2212 by 1659 pixels — 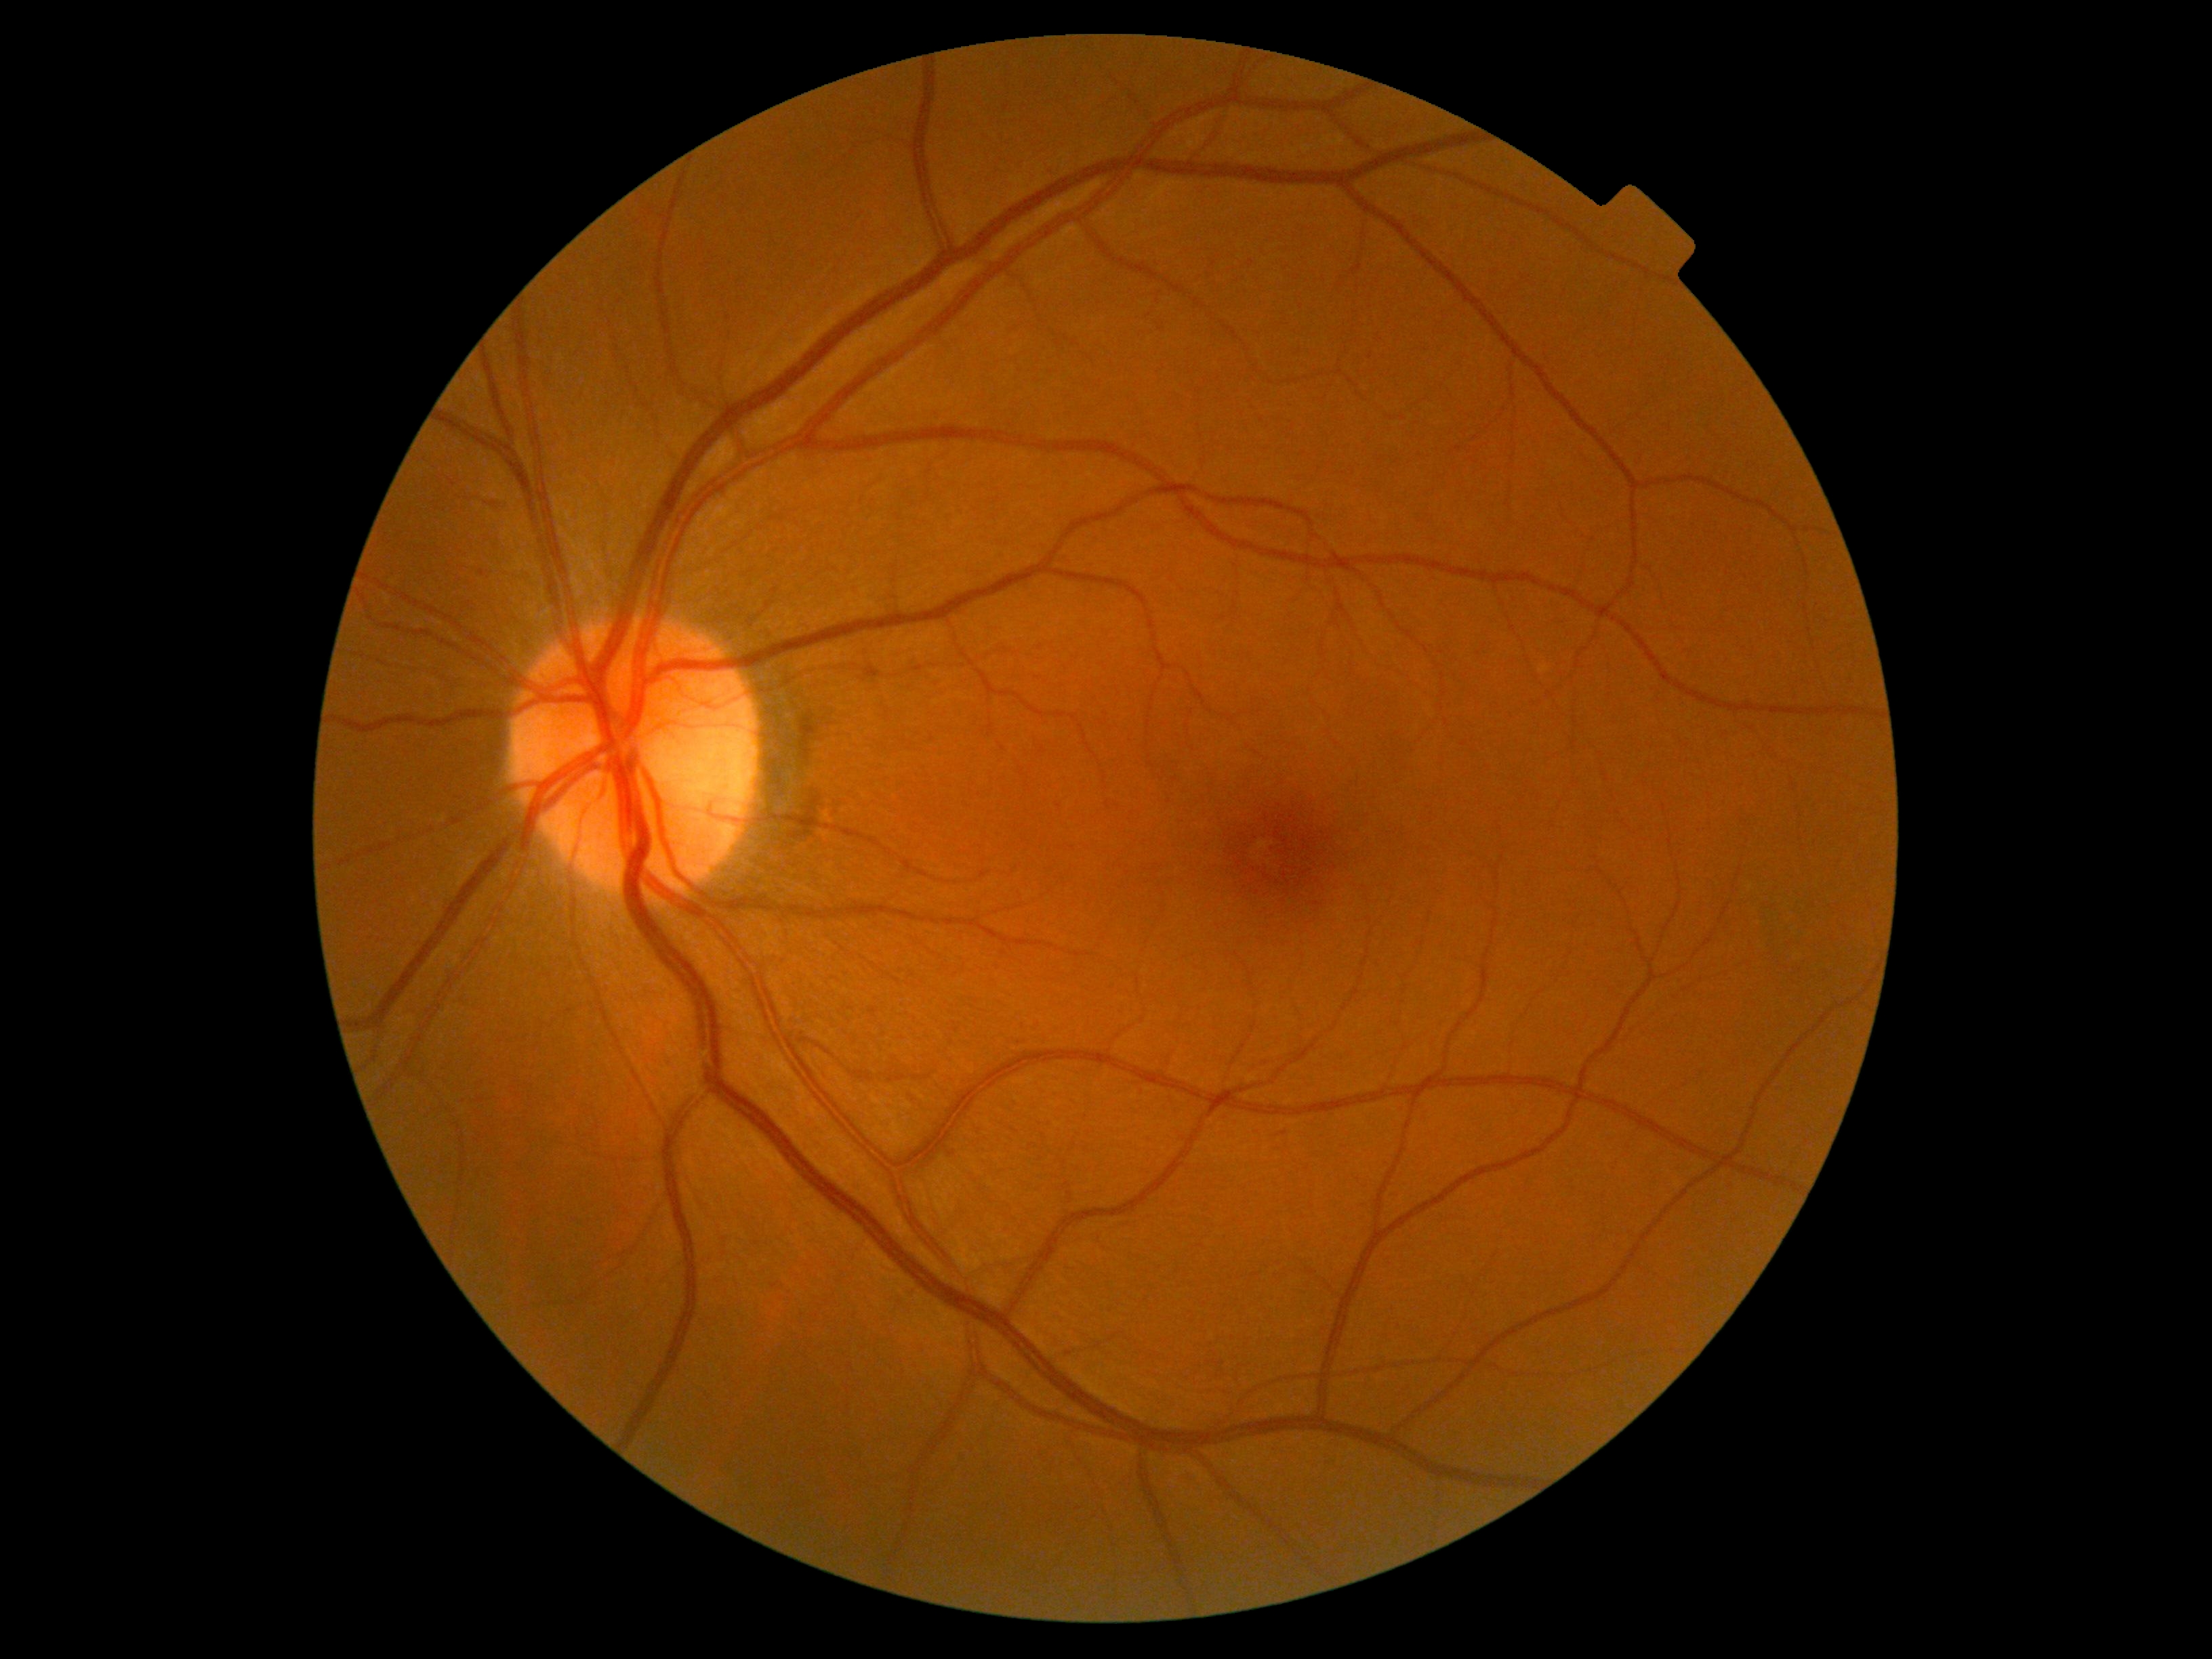 retinopathy grade=0.